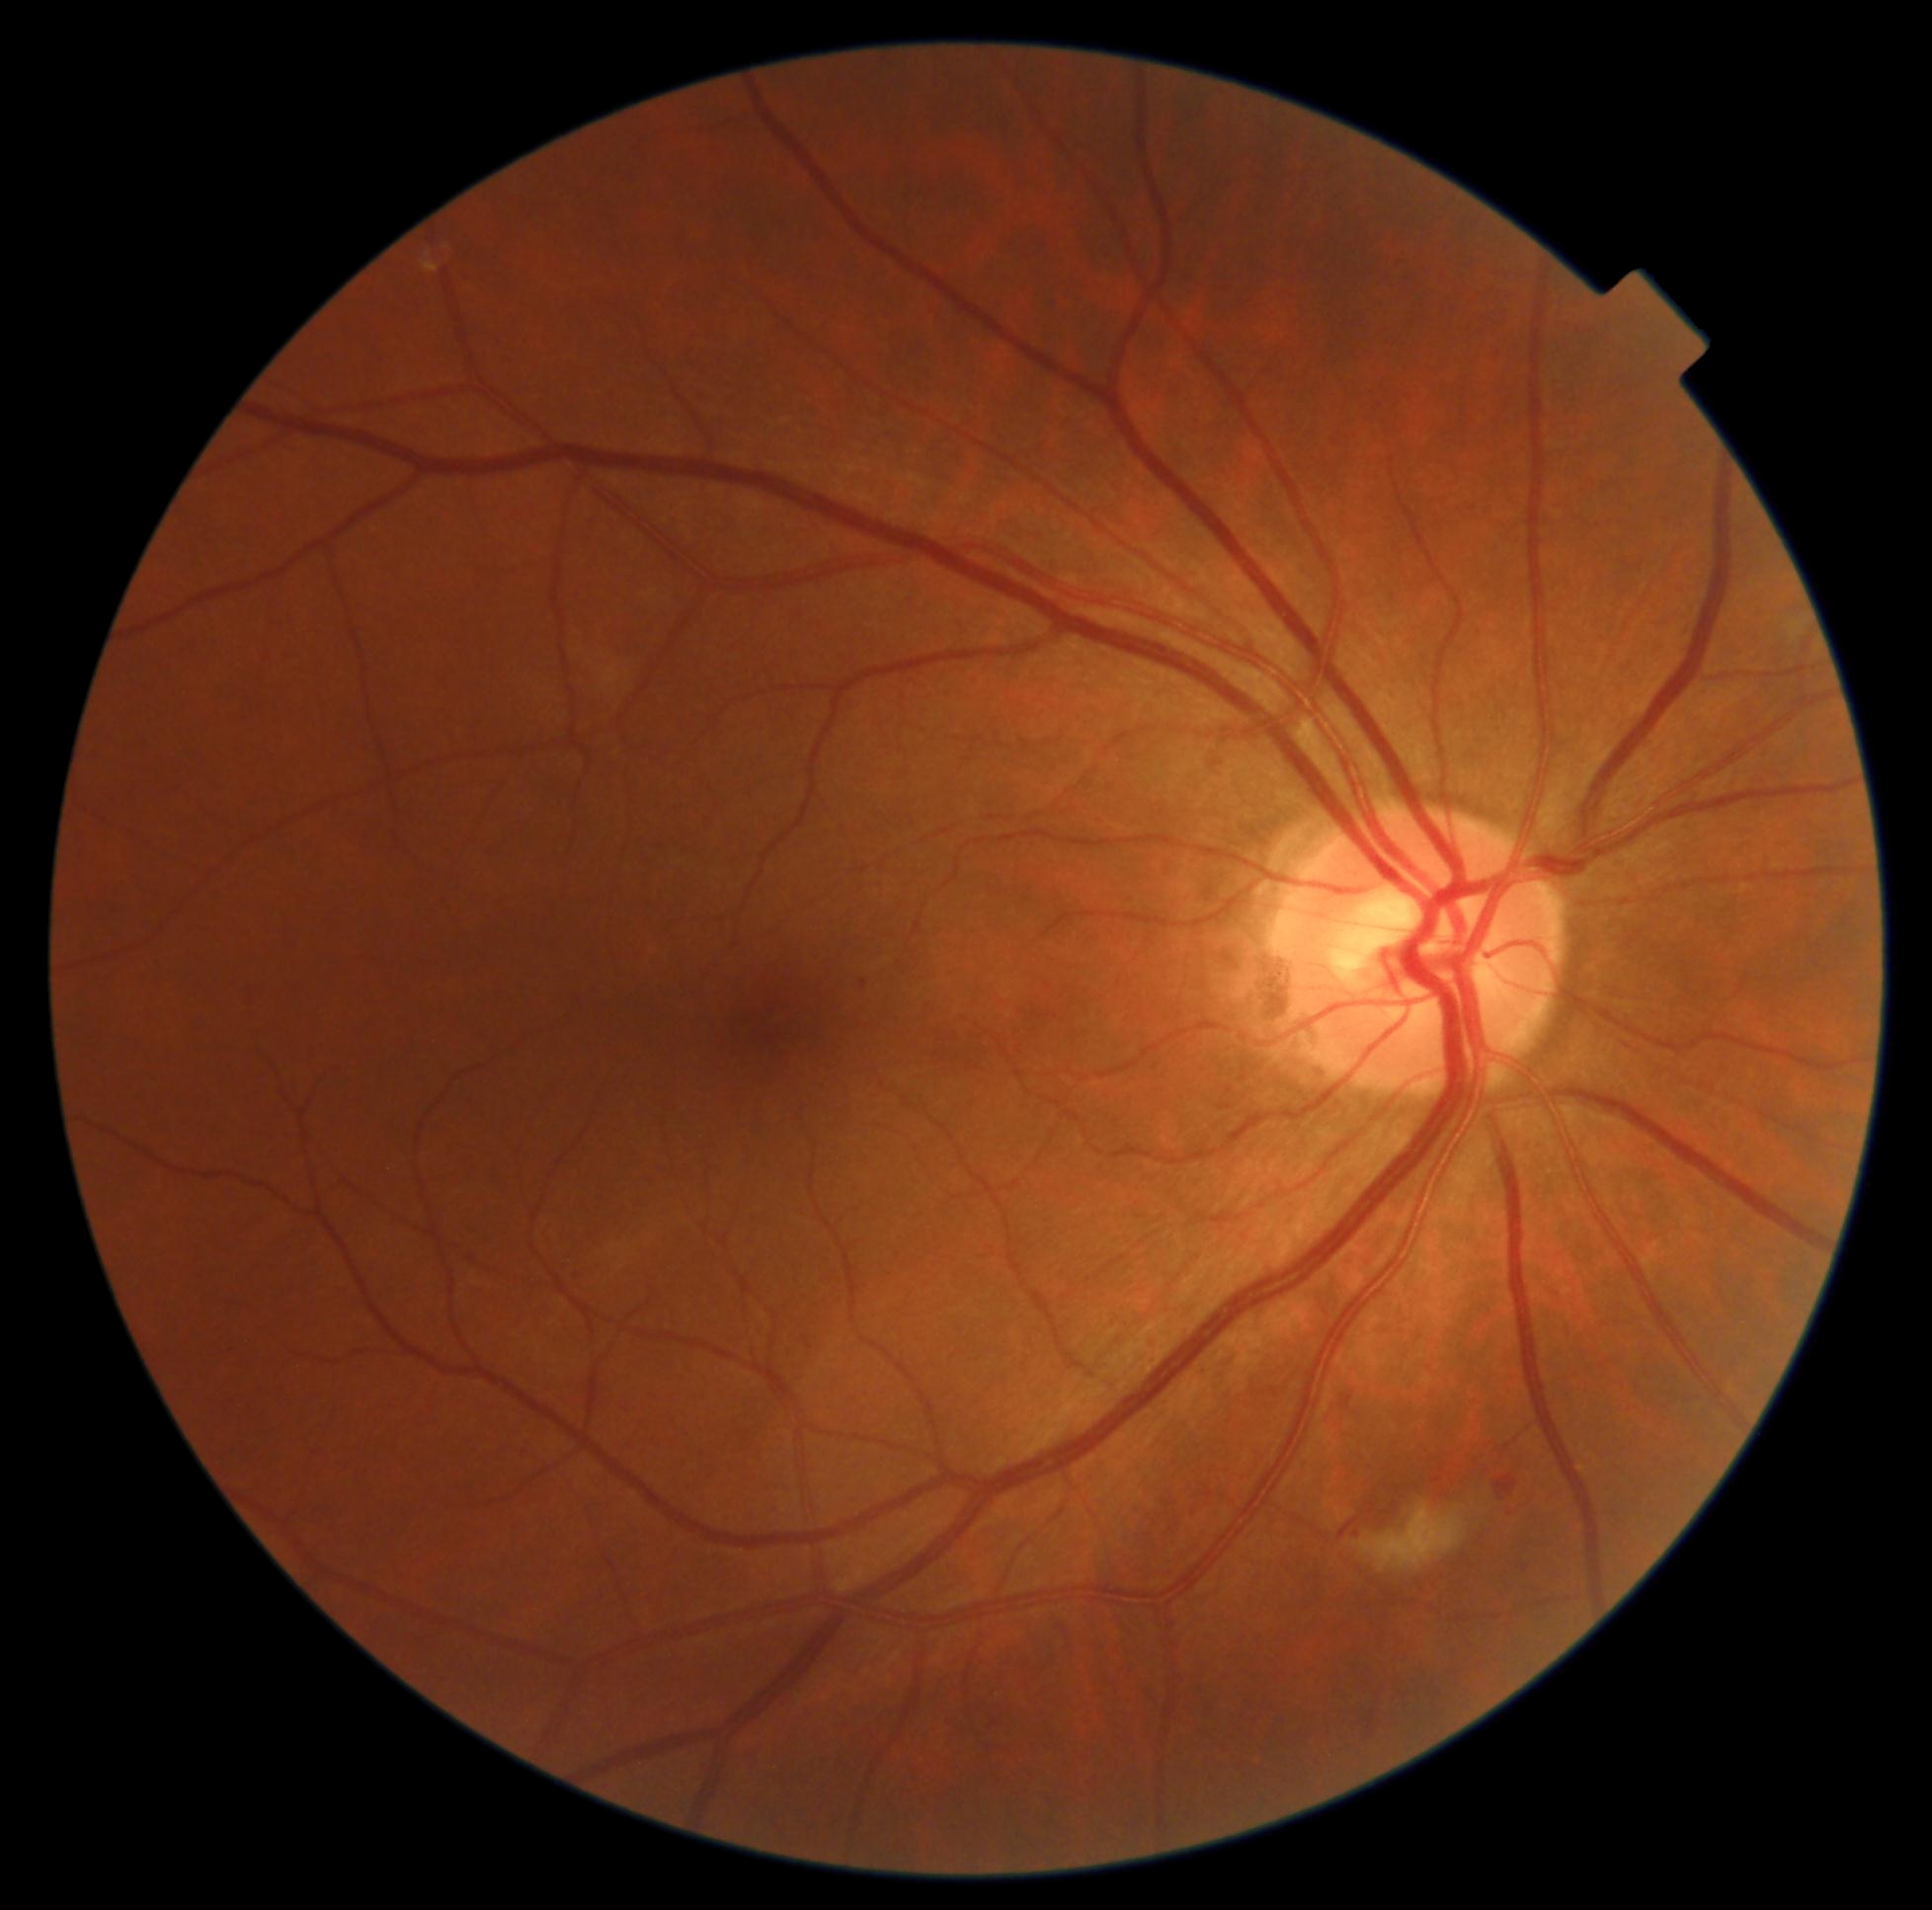

DR severity@grade 2 — more than just microaneurysms but less than severe NPDR.